45-degree field of view.
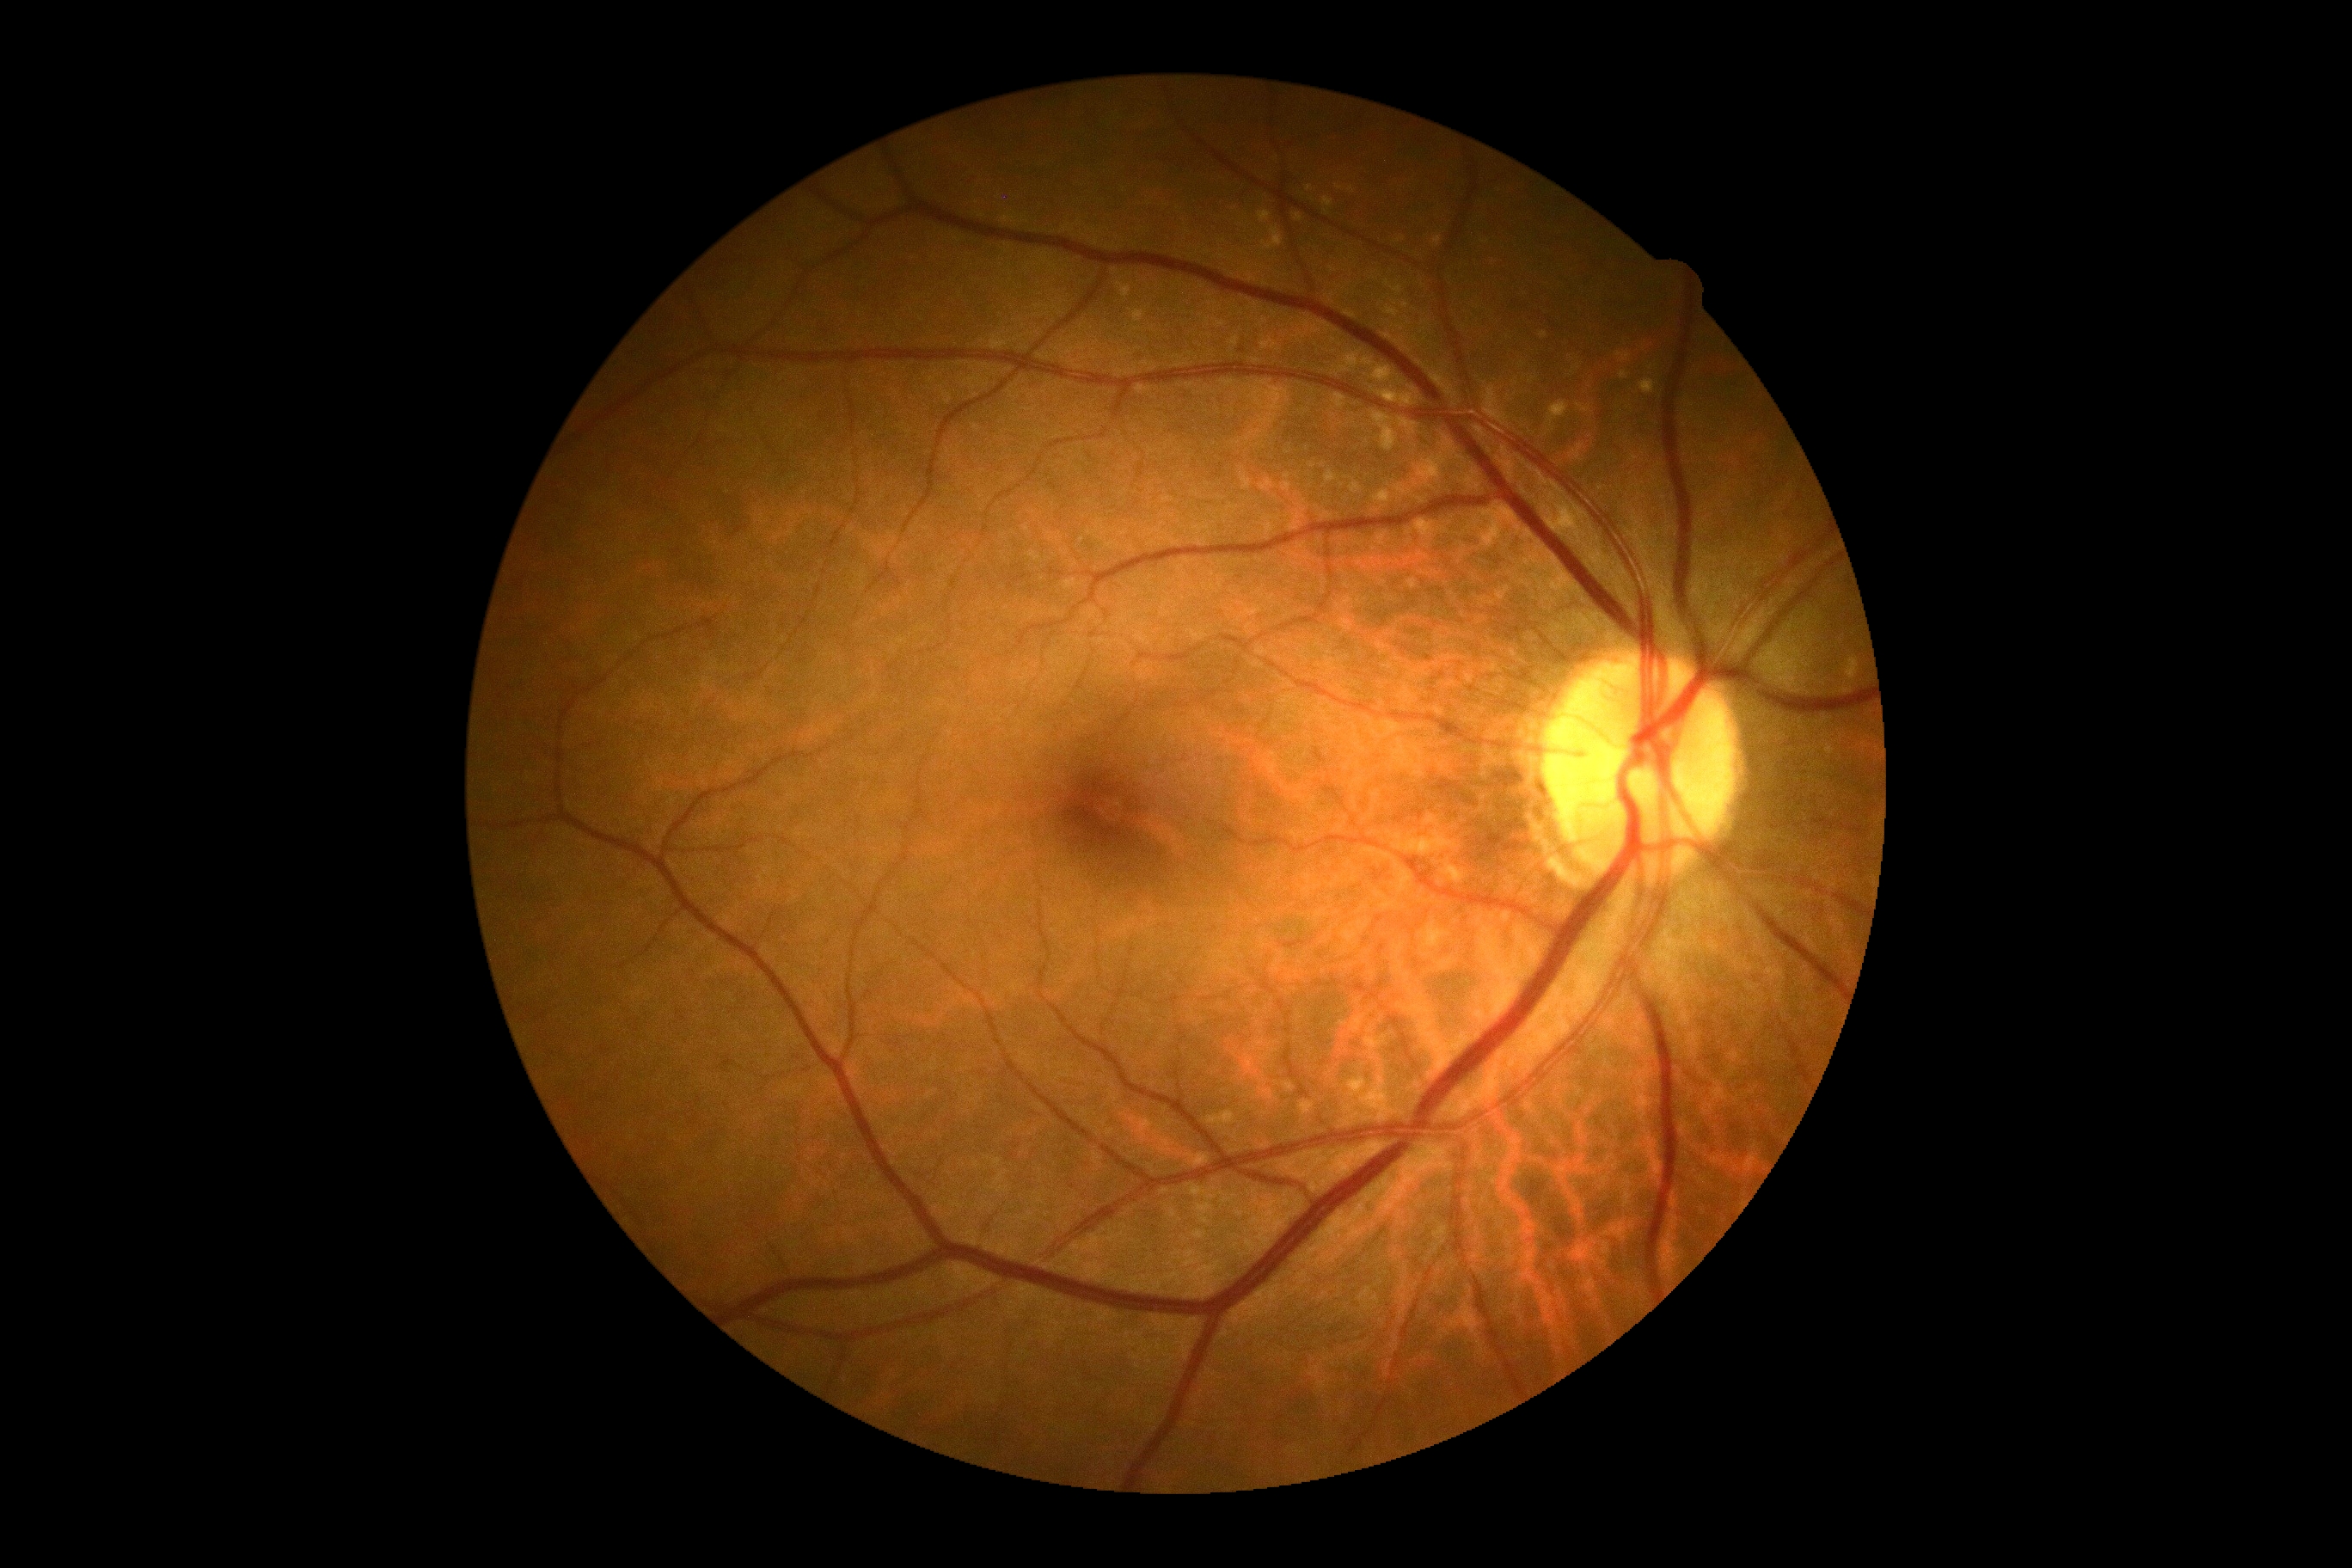

DR is no apparent retinopathy (grade 0).
No apparent diabetic retinopathy.